Retinal fundus photograph: 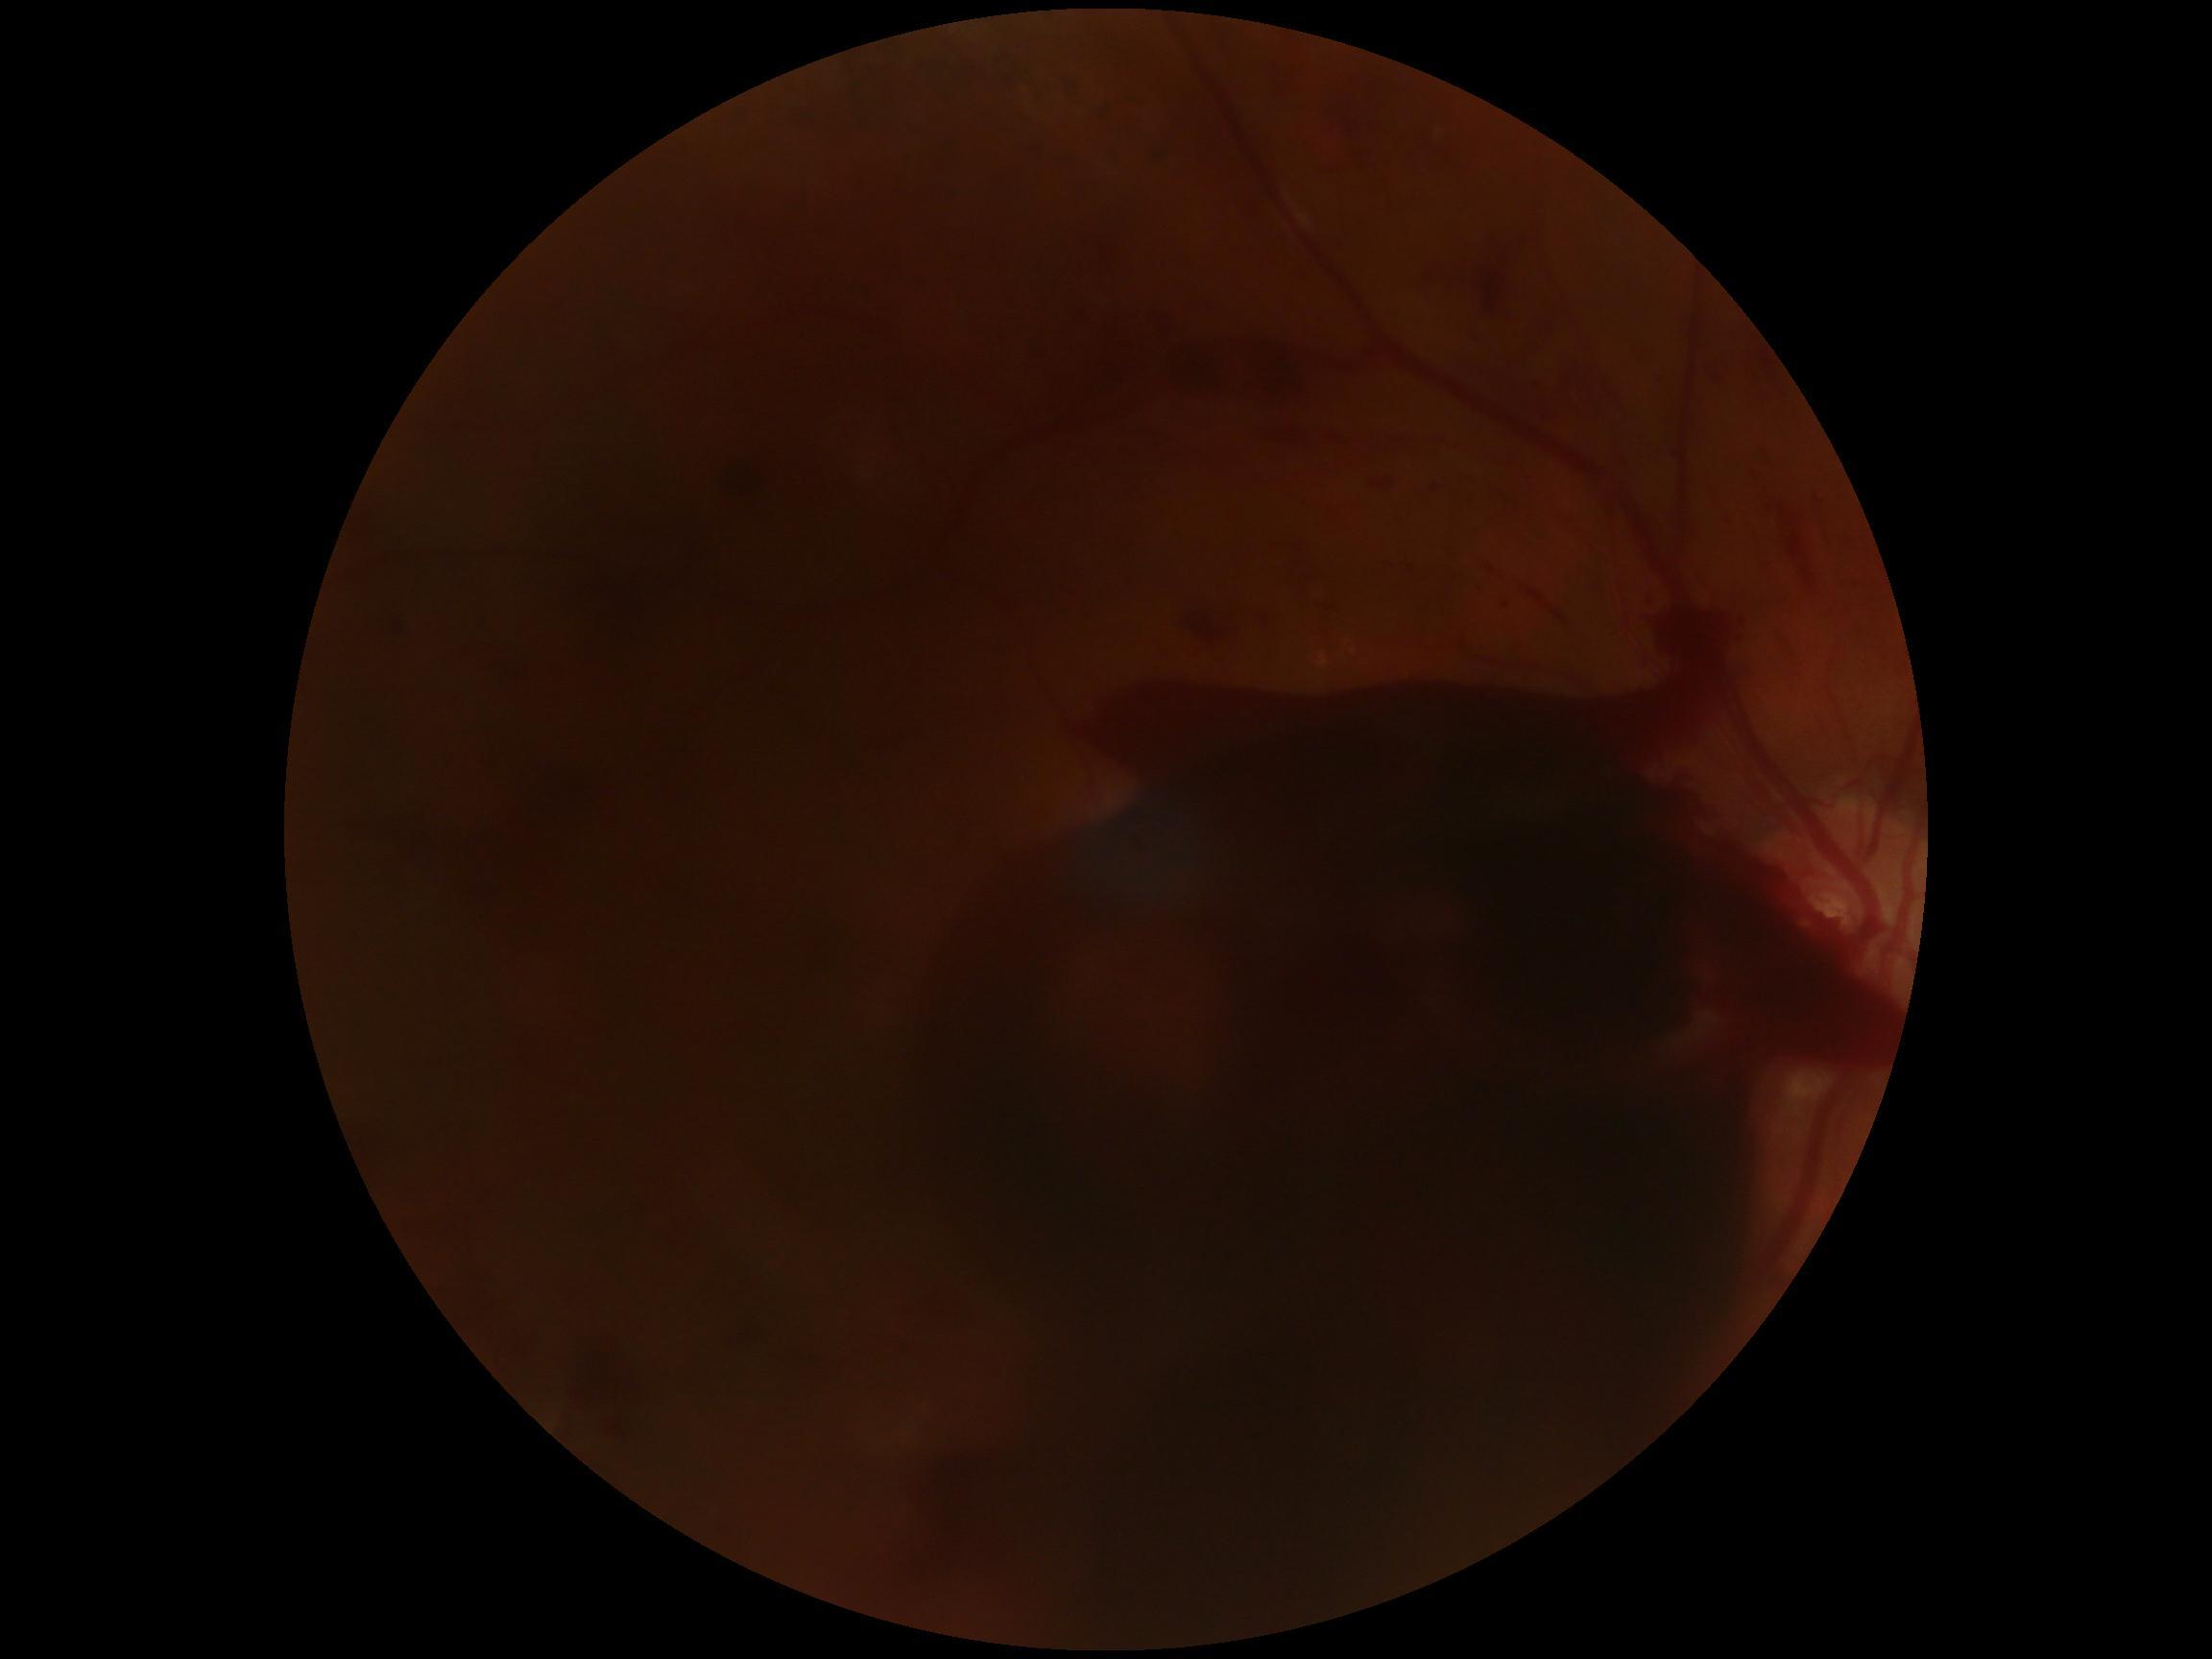 DR stage: 4/4.